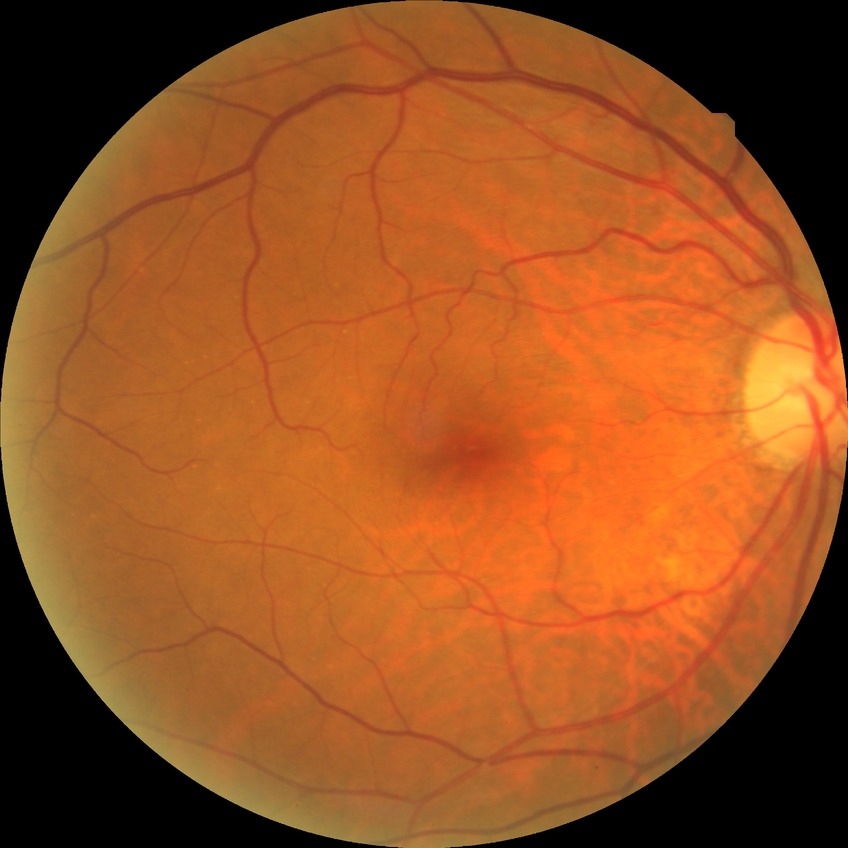 Assessment:
• DR impression: no DR findings
• DR: NDR